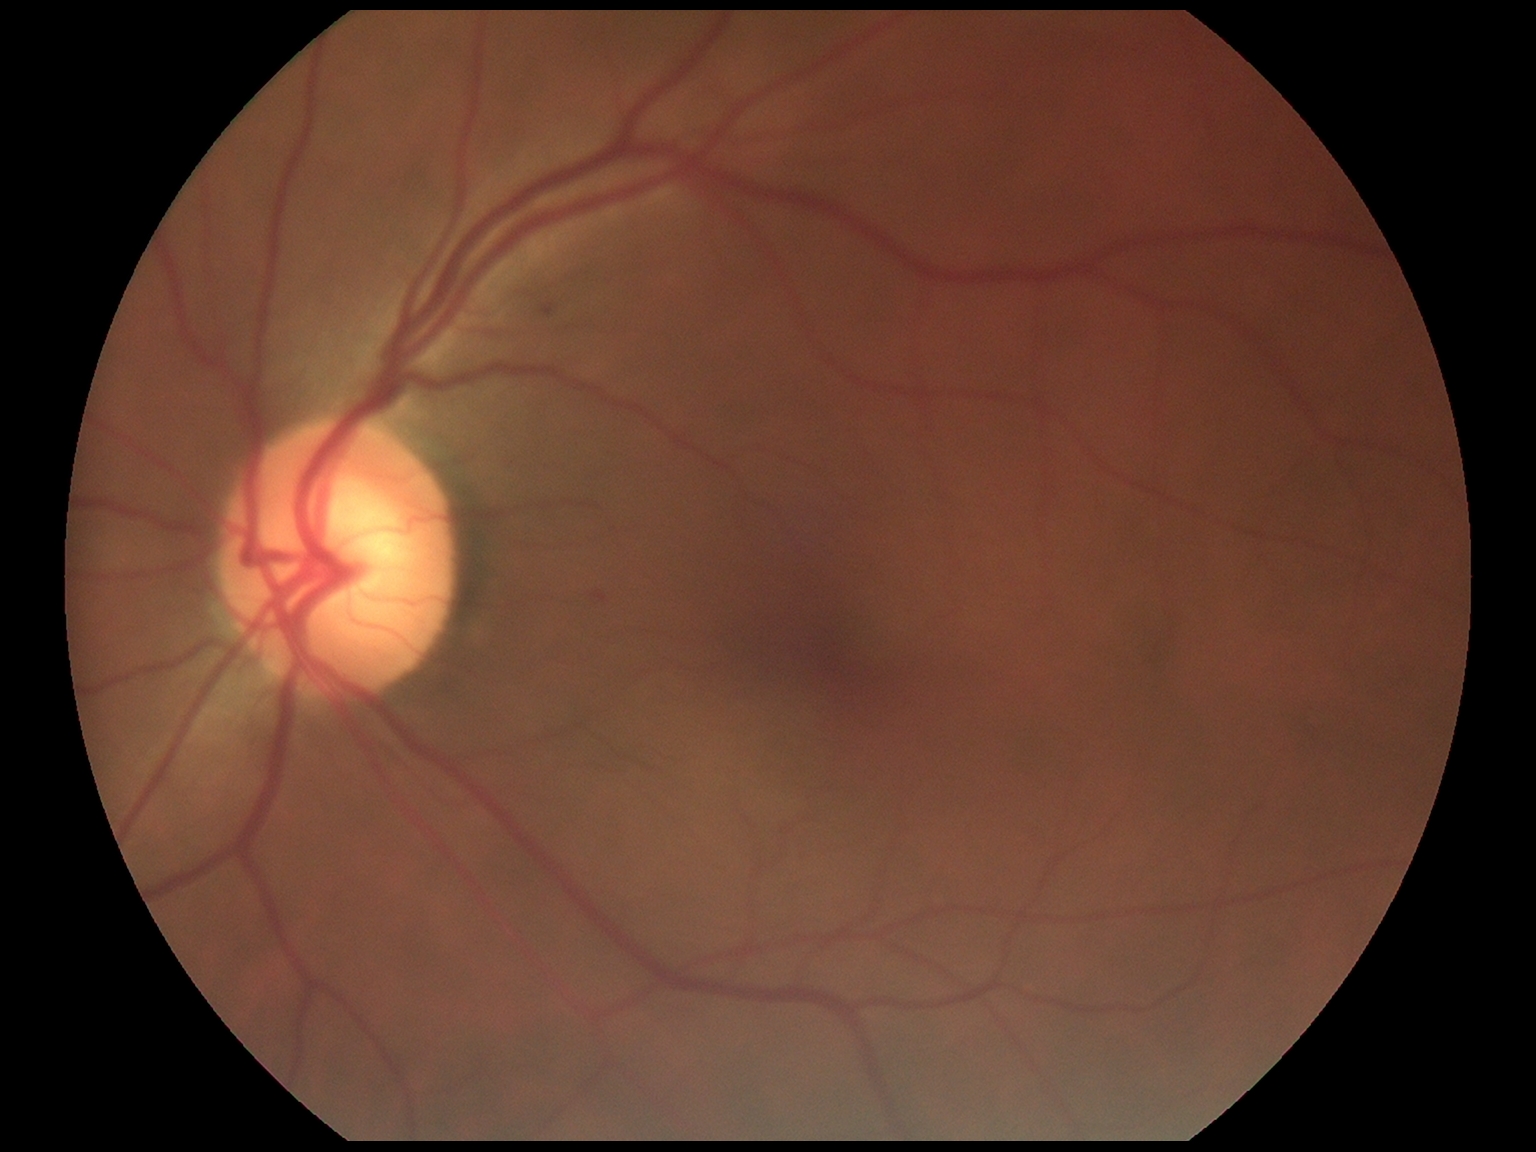 DR grade: 1/4.